Posterior pole photograph; DR severity per modified Davis staging
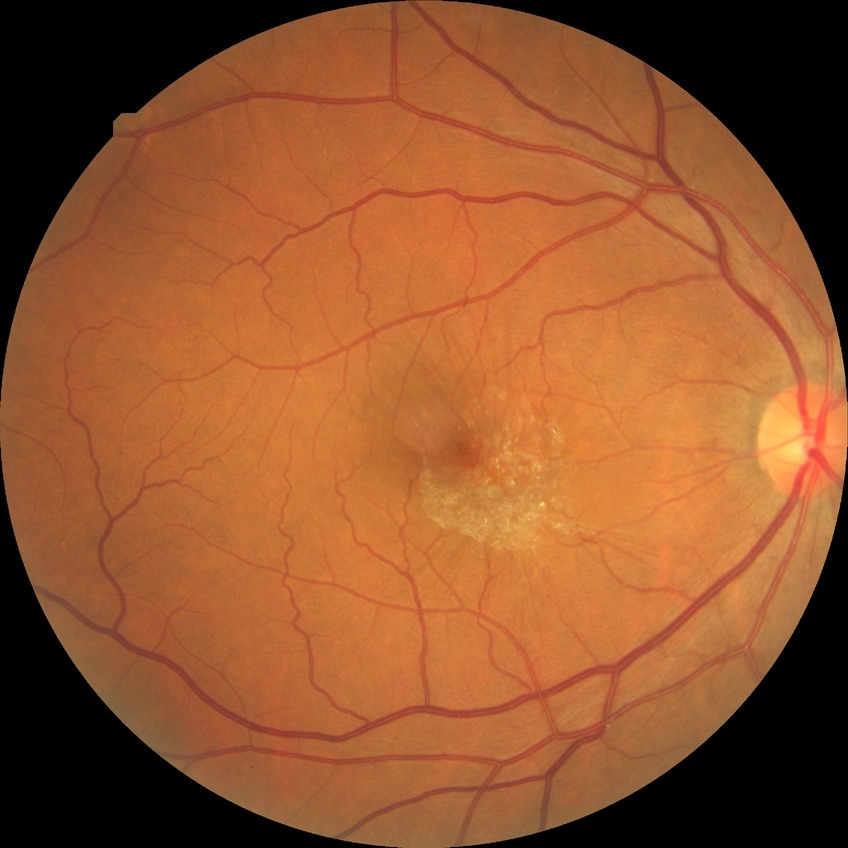 Diabetic retinopathy (DR) is NDR (no diabetic retinopathy).